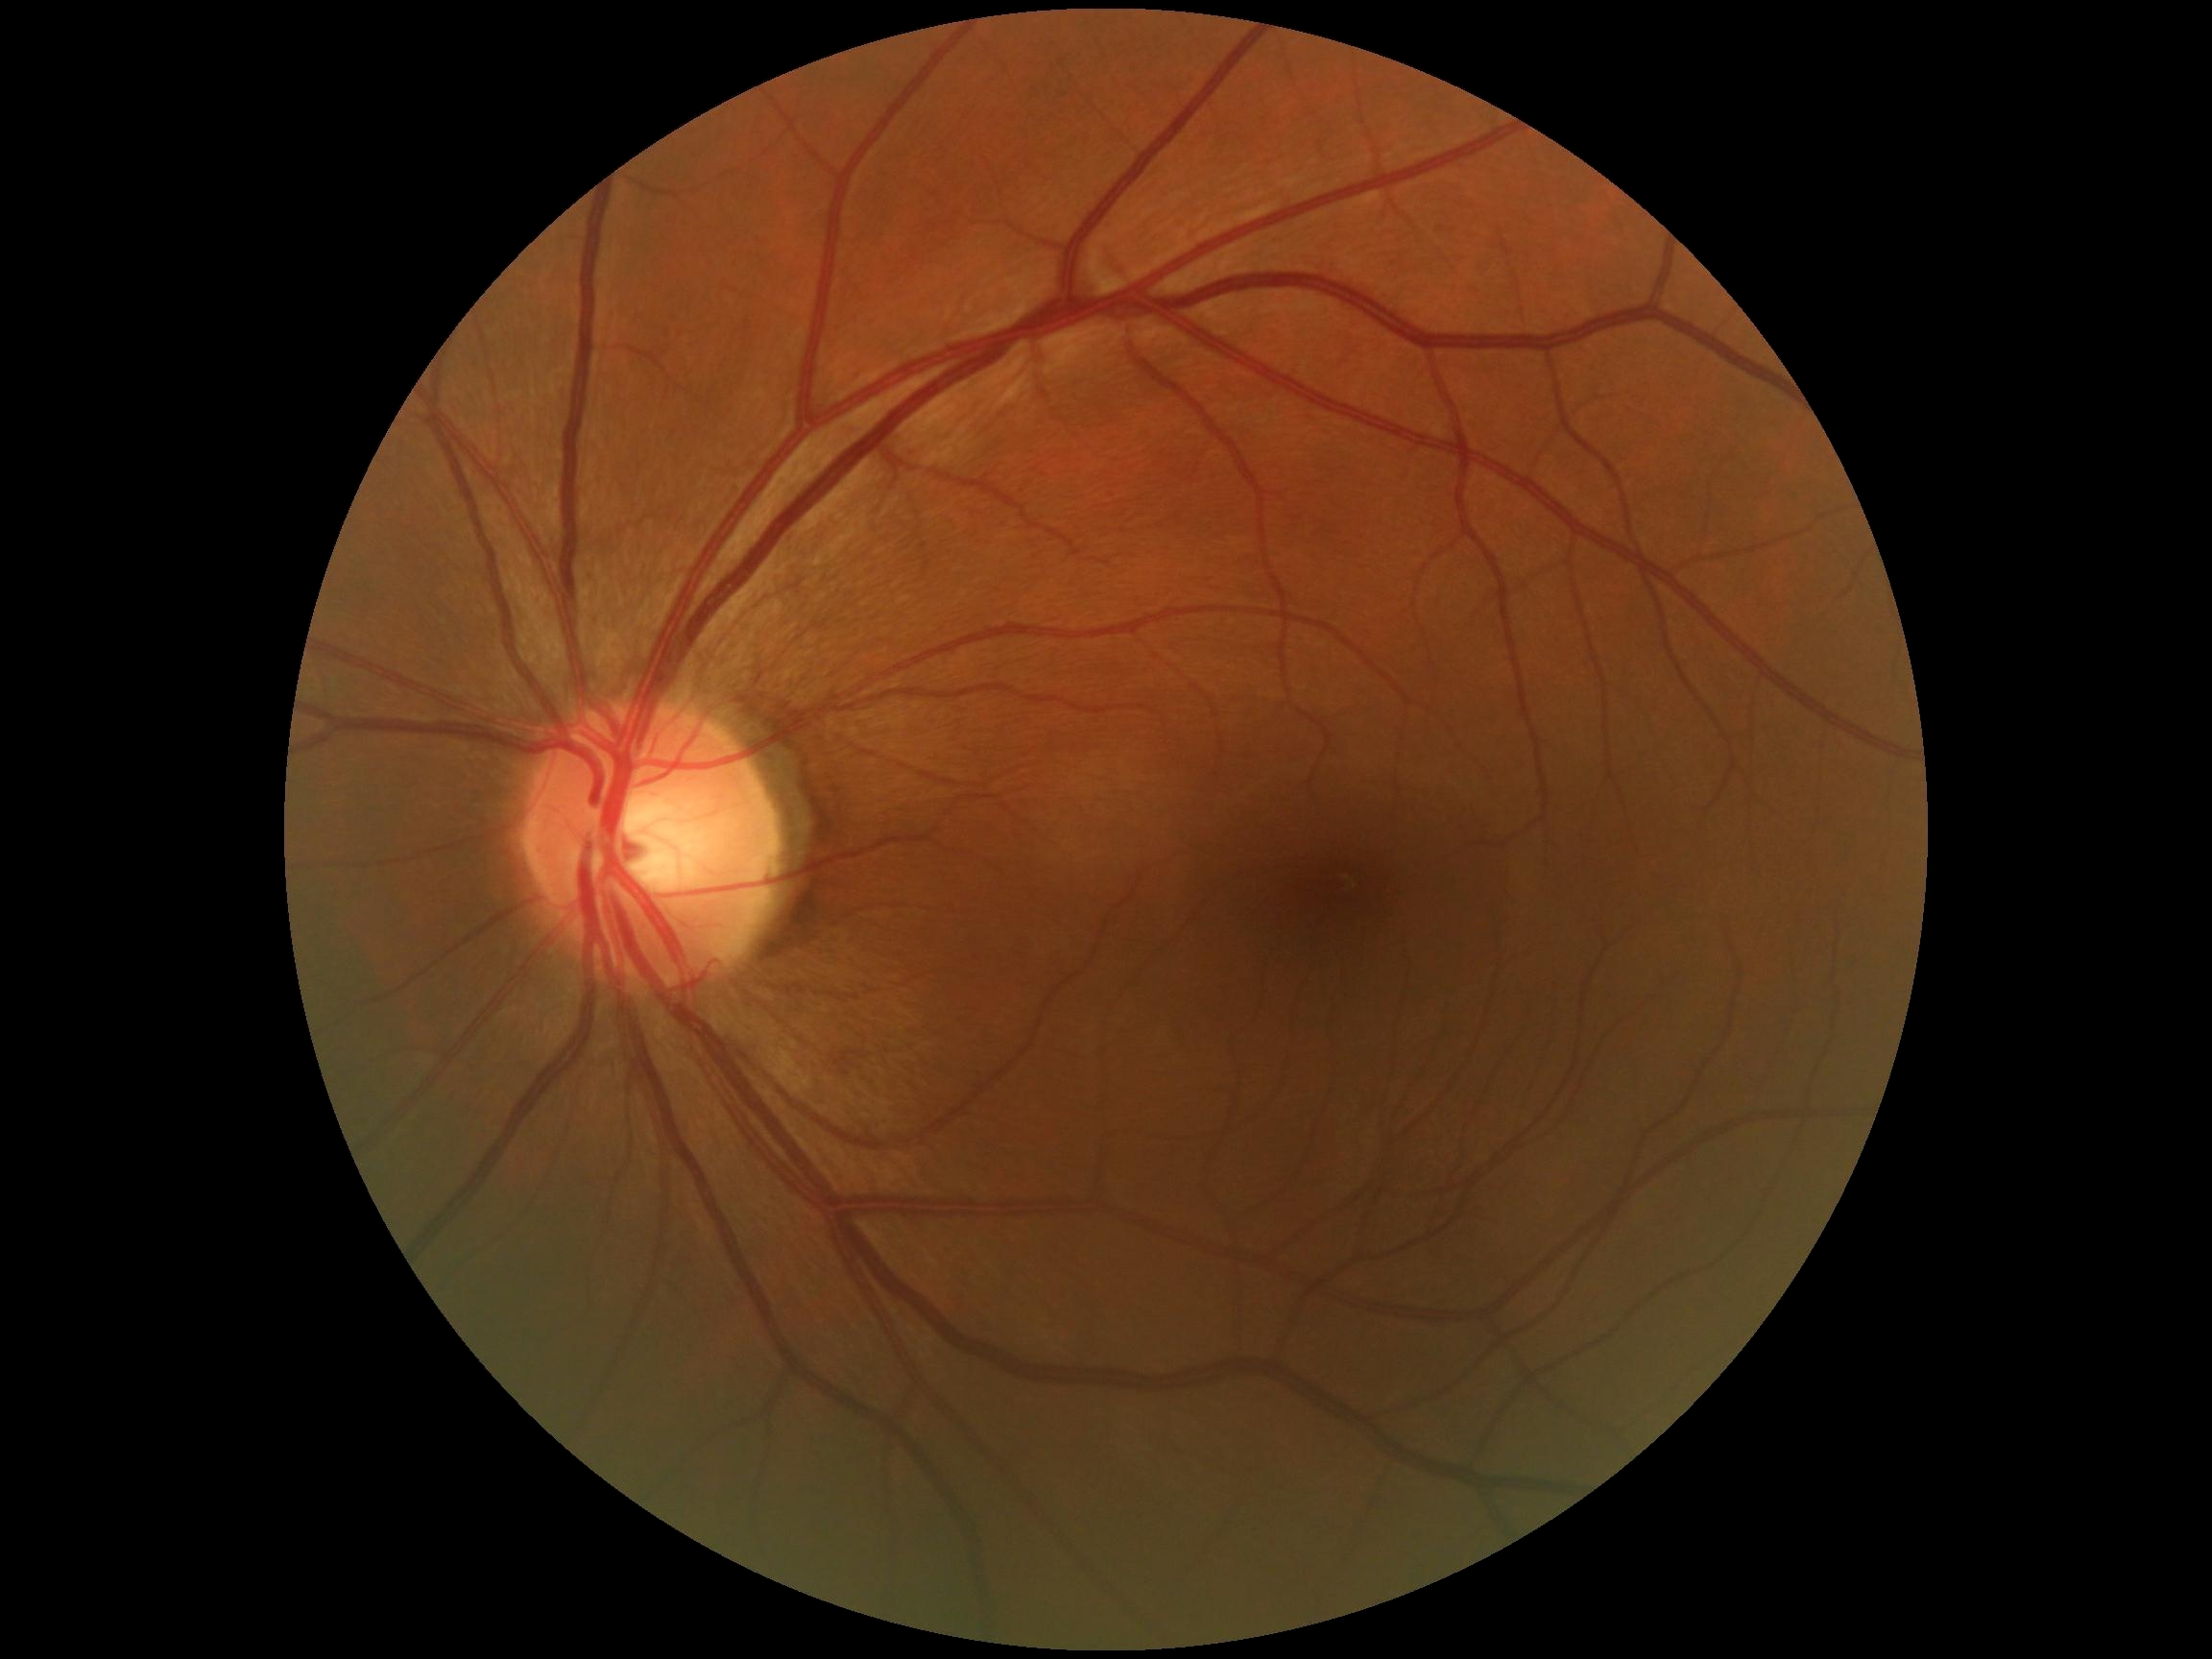

DR stage: grade 0 (no apparent retinopathy). No DR findings.